45° field of view; fundus photo.
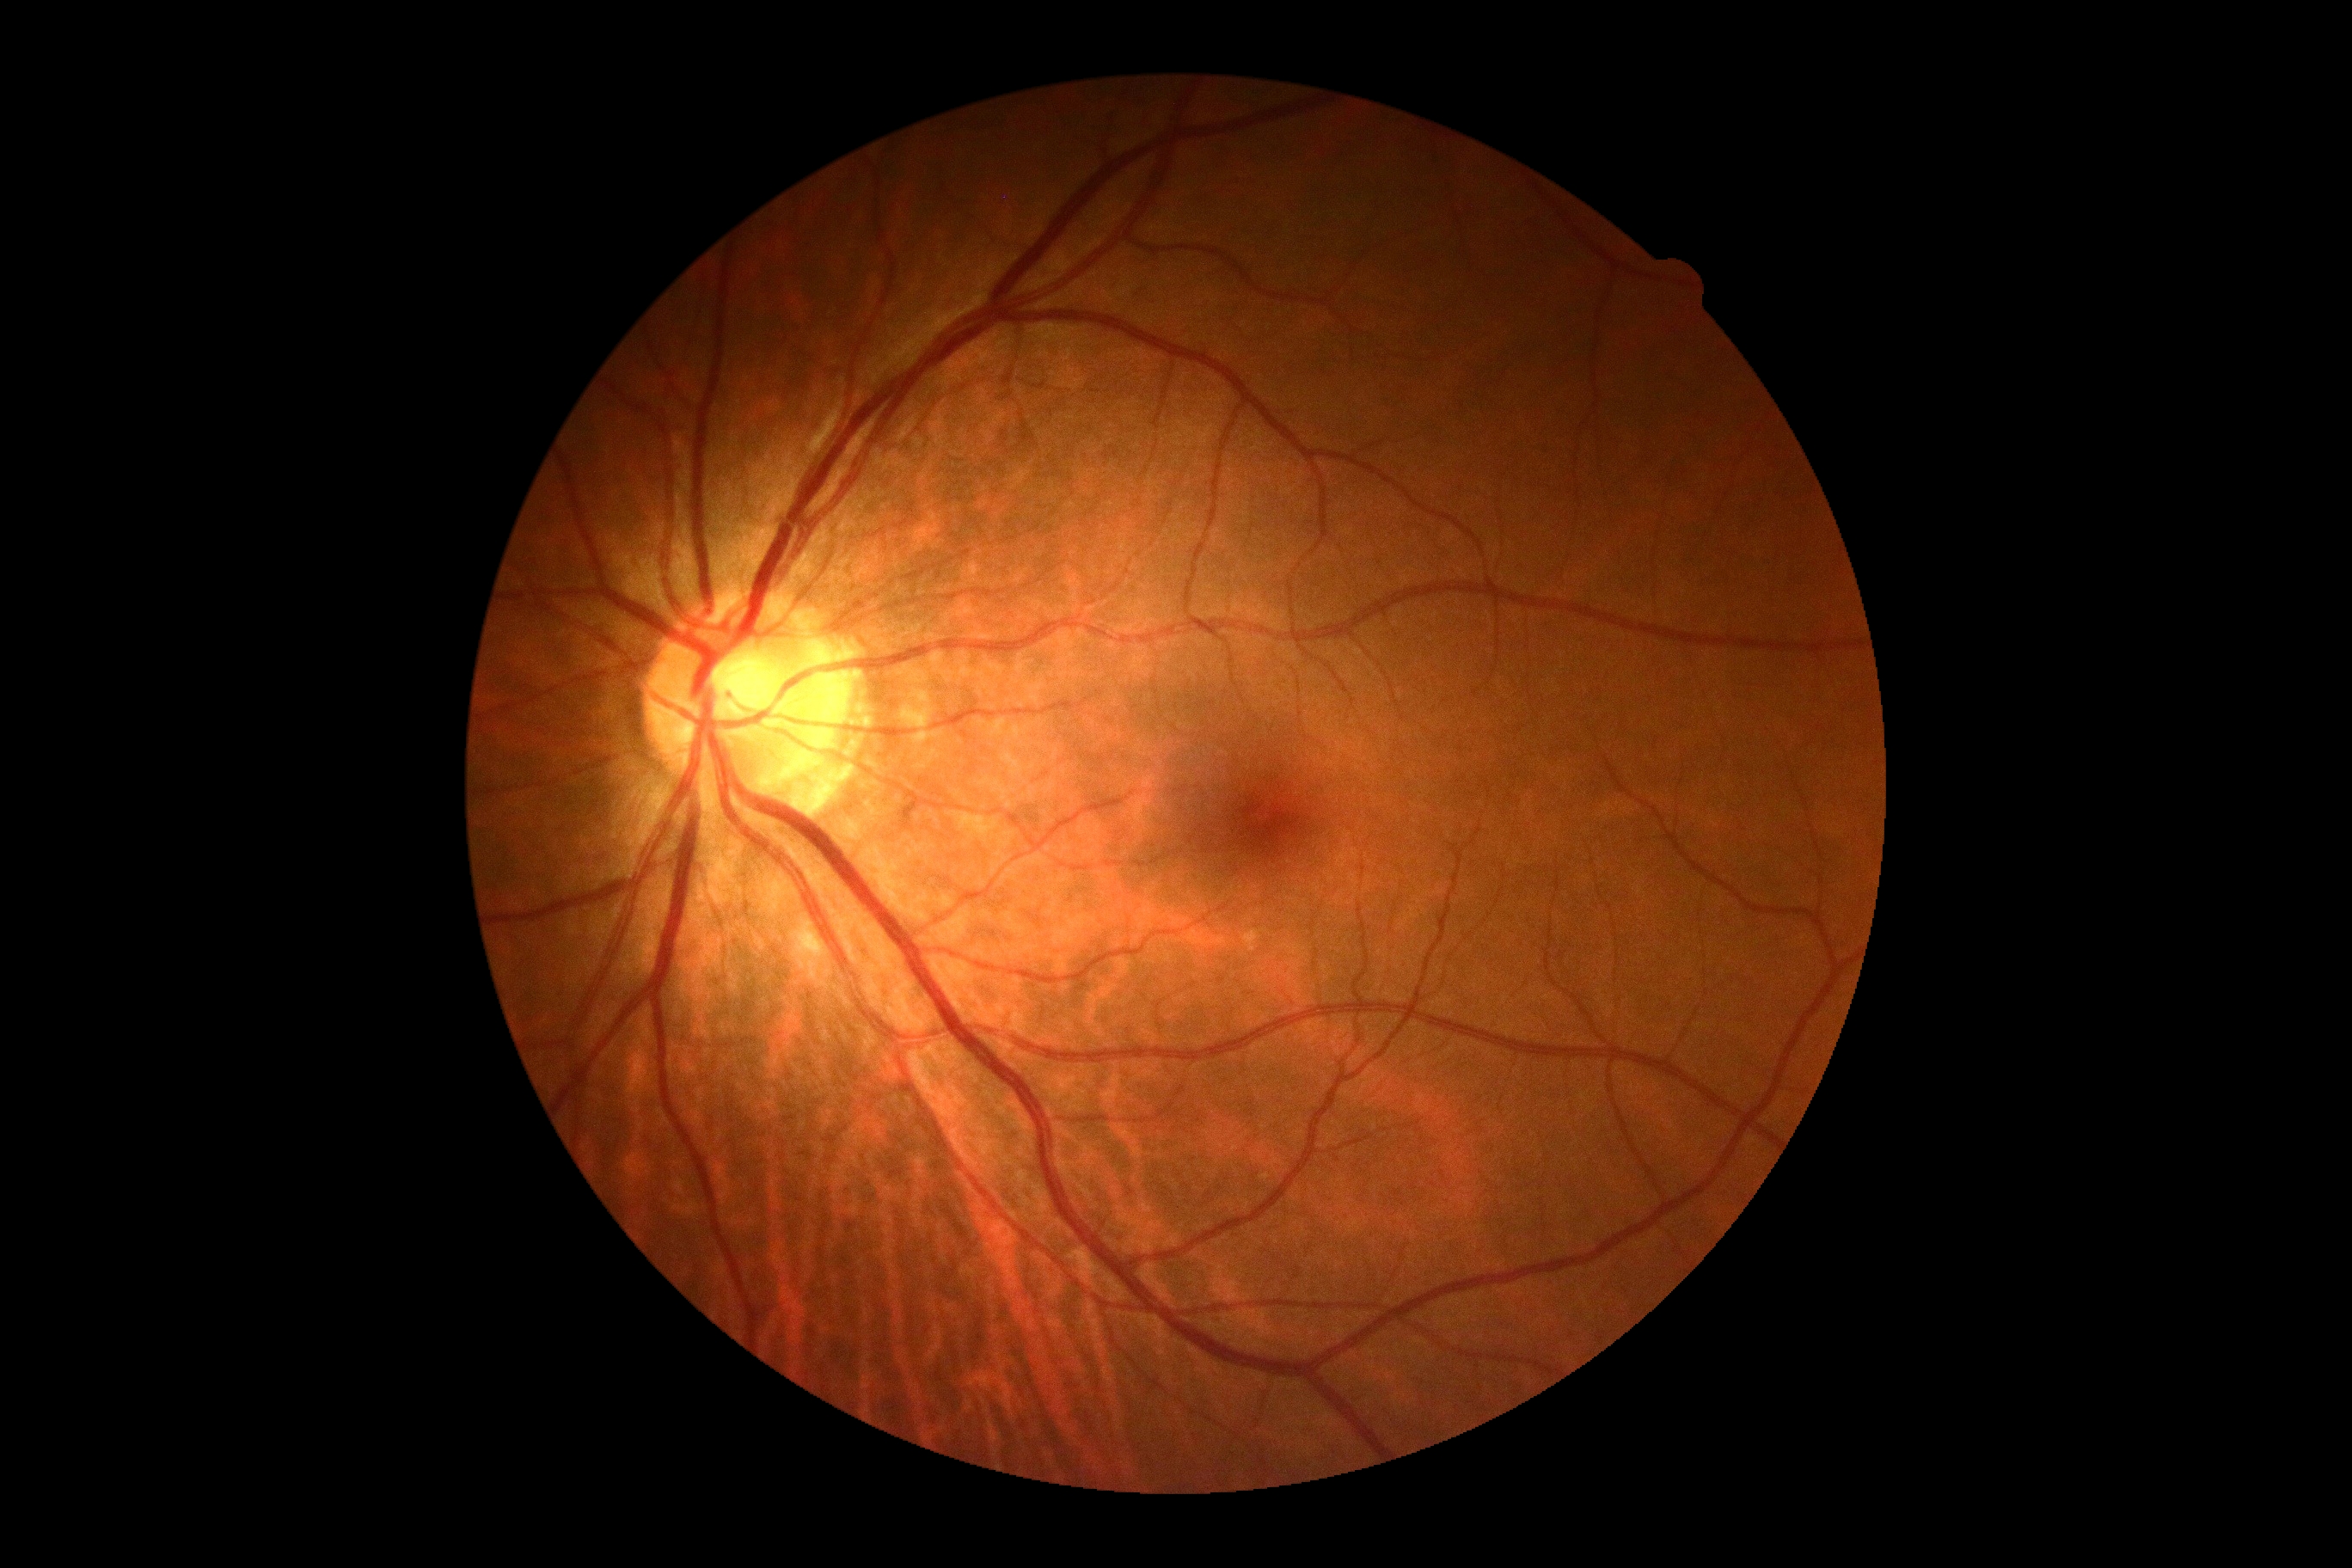

{
  "dr_impression": "no DR findings",
  "dr_grade": "no apparent retinopathy (grade 0) — no visible signs of diabetic retinopathy"
}